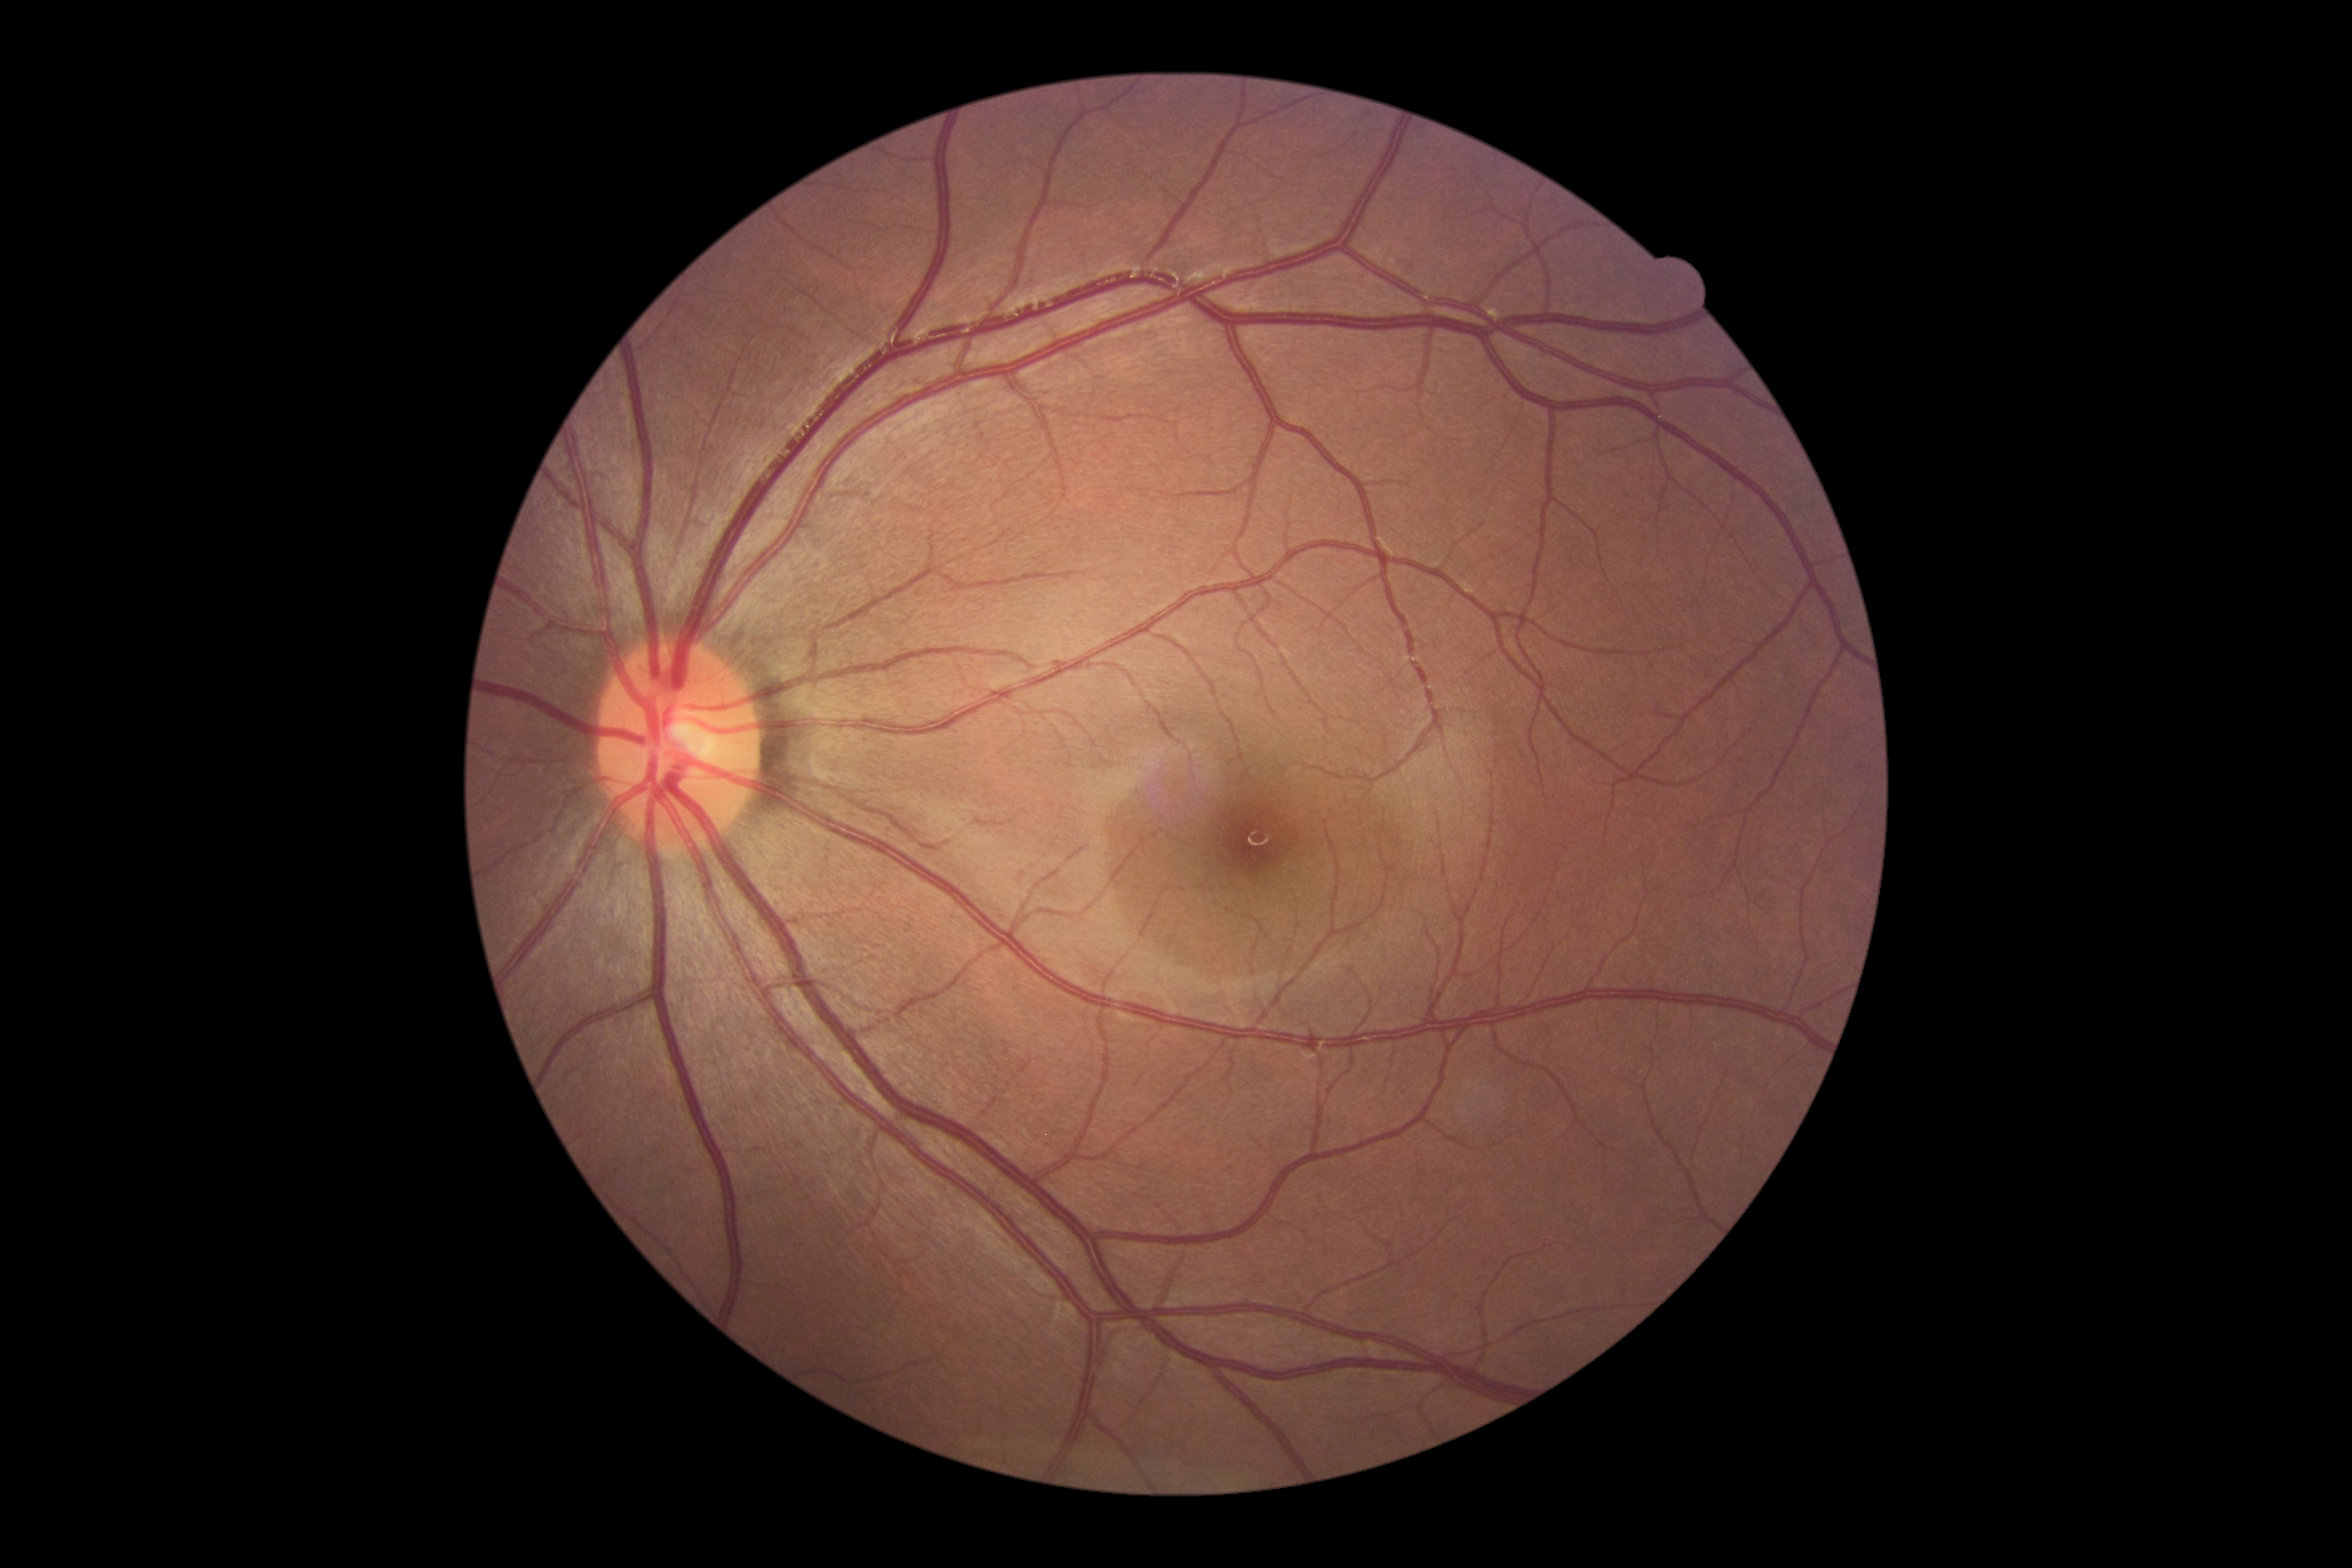
DR severity is 0/4.